Color fundus image. 45° FOV. 2352 by 1568 pixels:
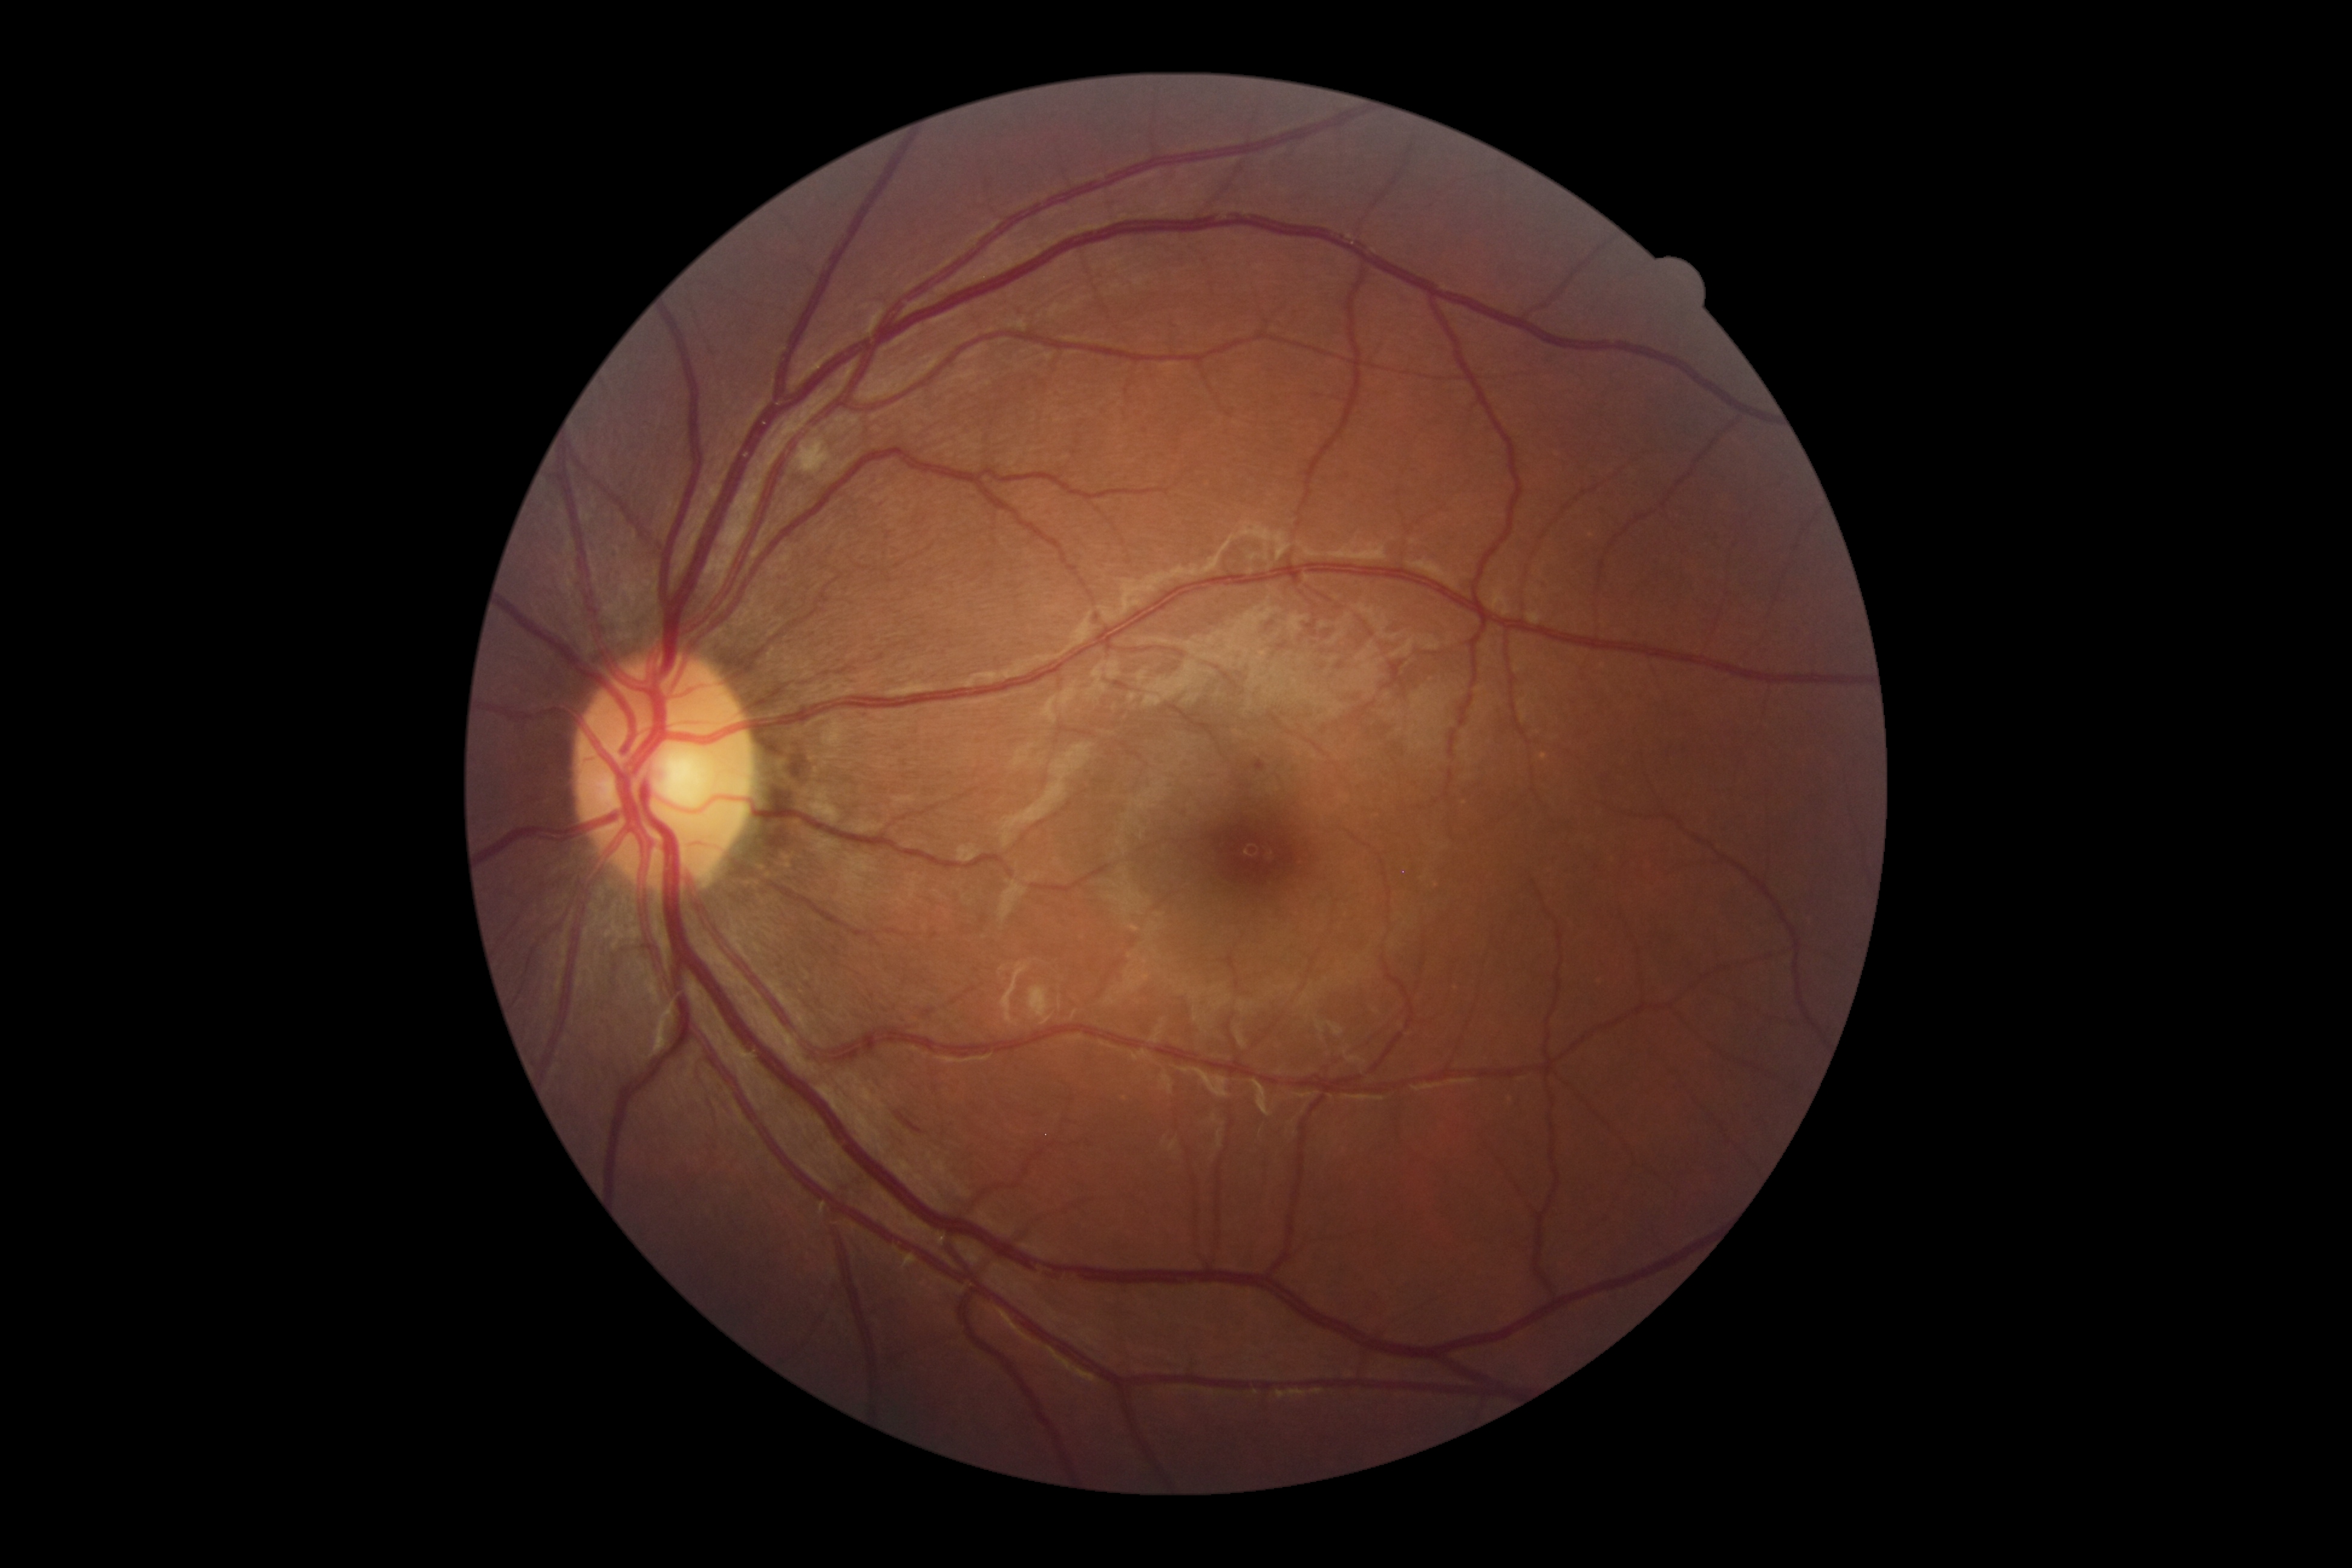

Findings:
- DR class: non-proliferative diabetic retinopathy
- retinopathy: 2